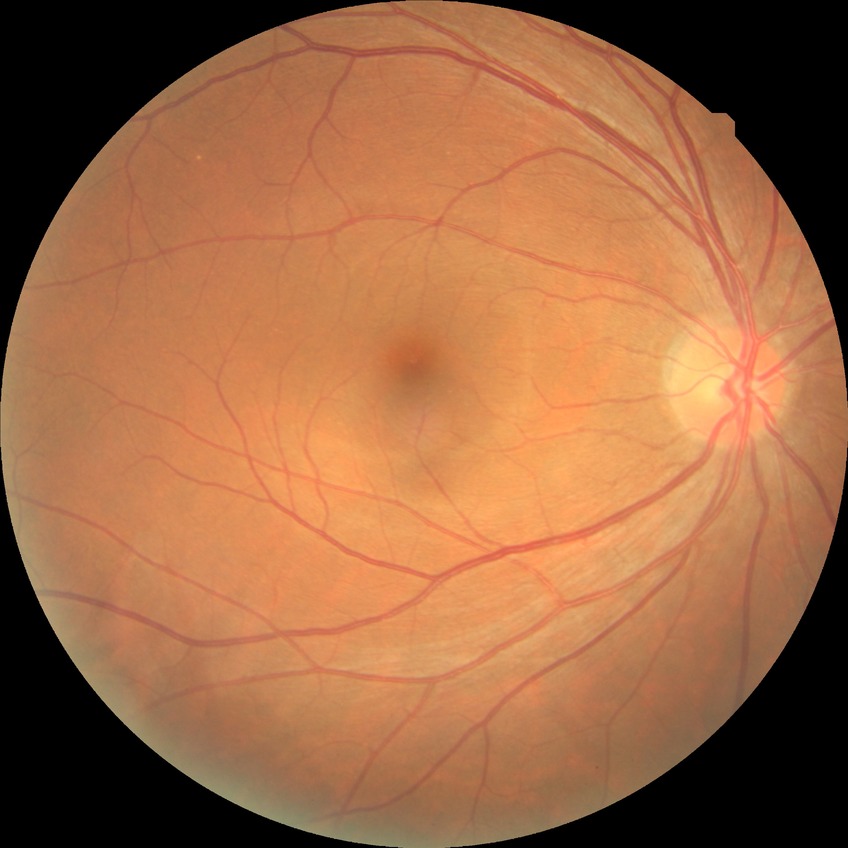
modified Davis grade: NDR, DR impression: no signs of DR.